Color fundus photograph: 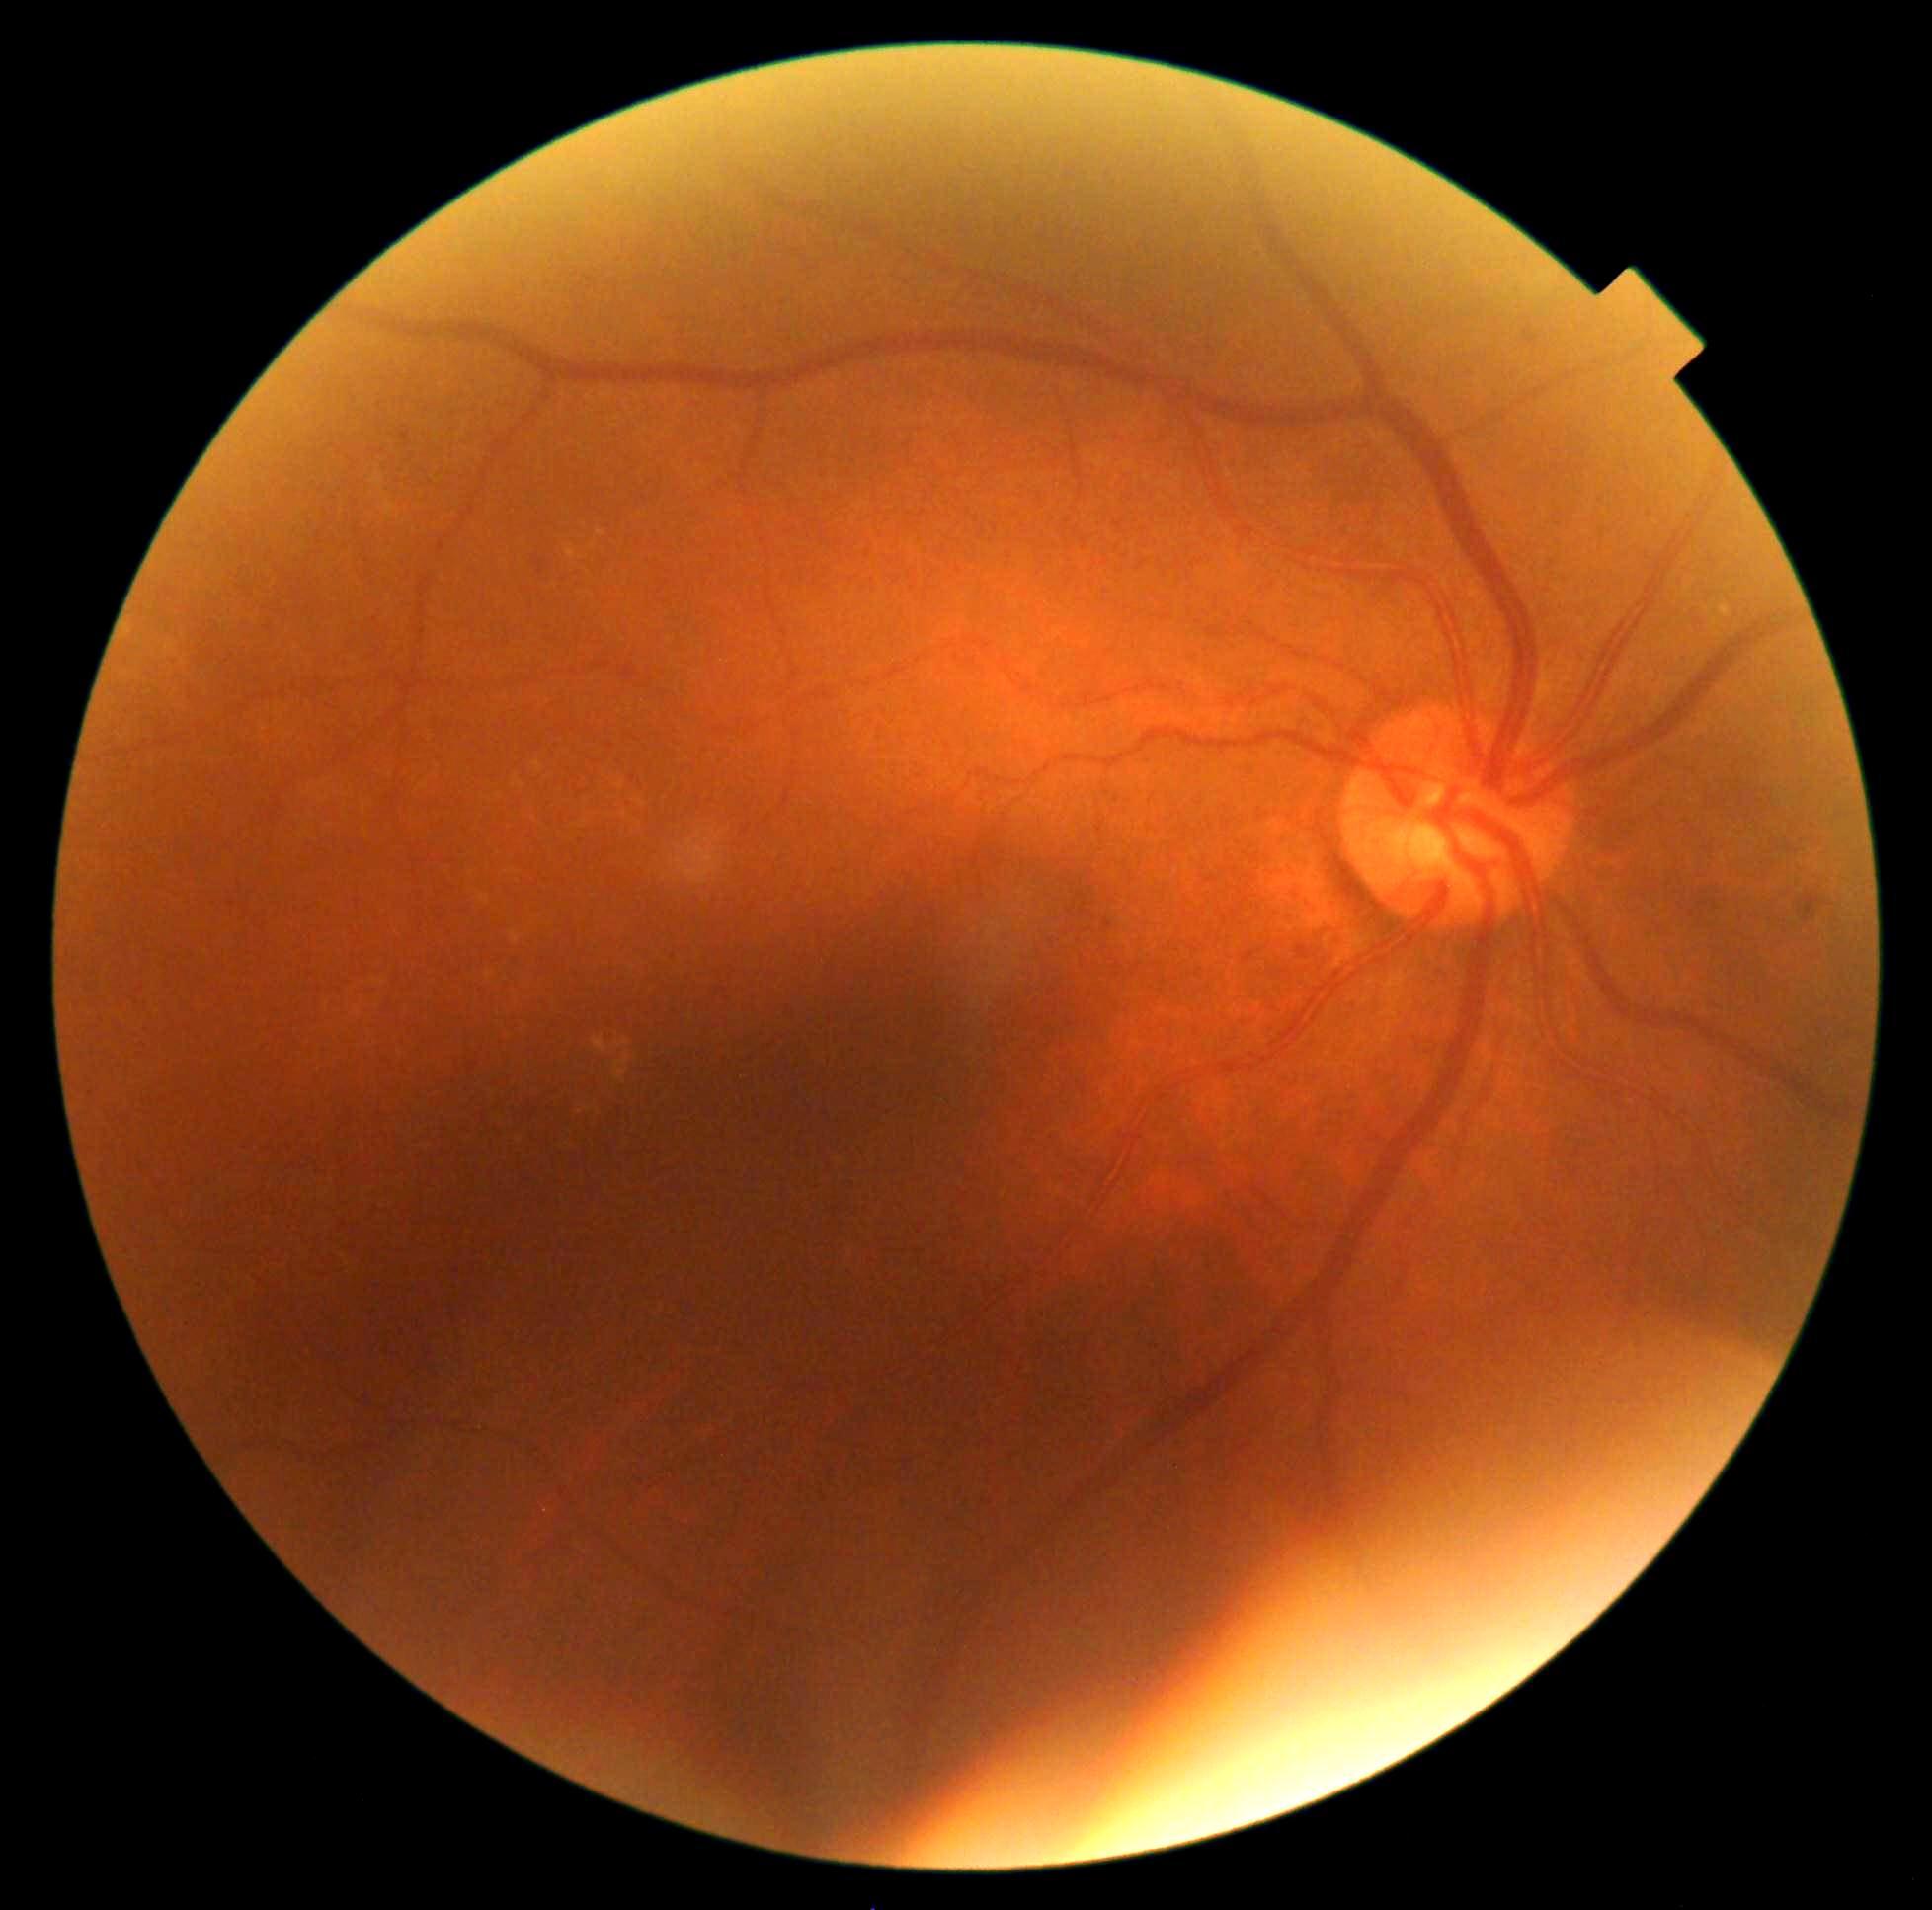

DR is moderate NPDR (grade 2). DR class: non-proliferative diabetic retinopathy.